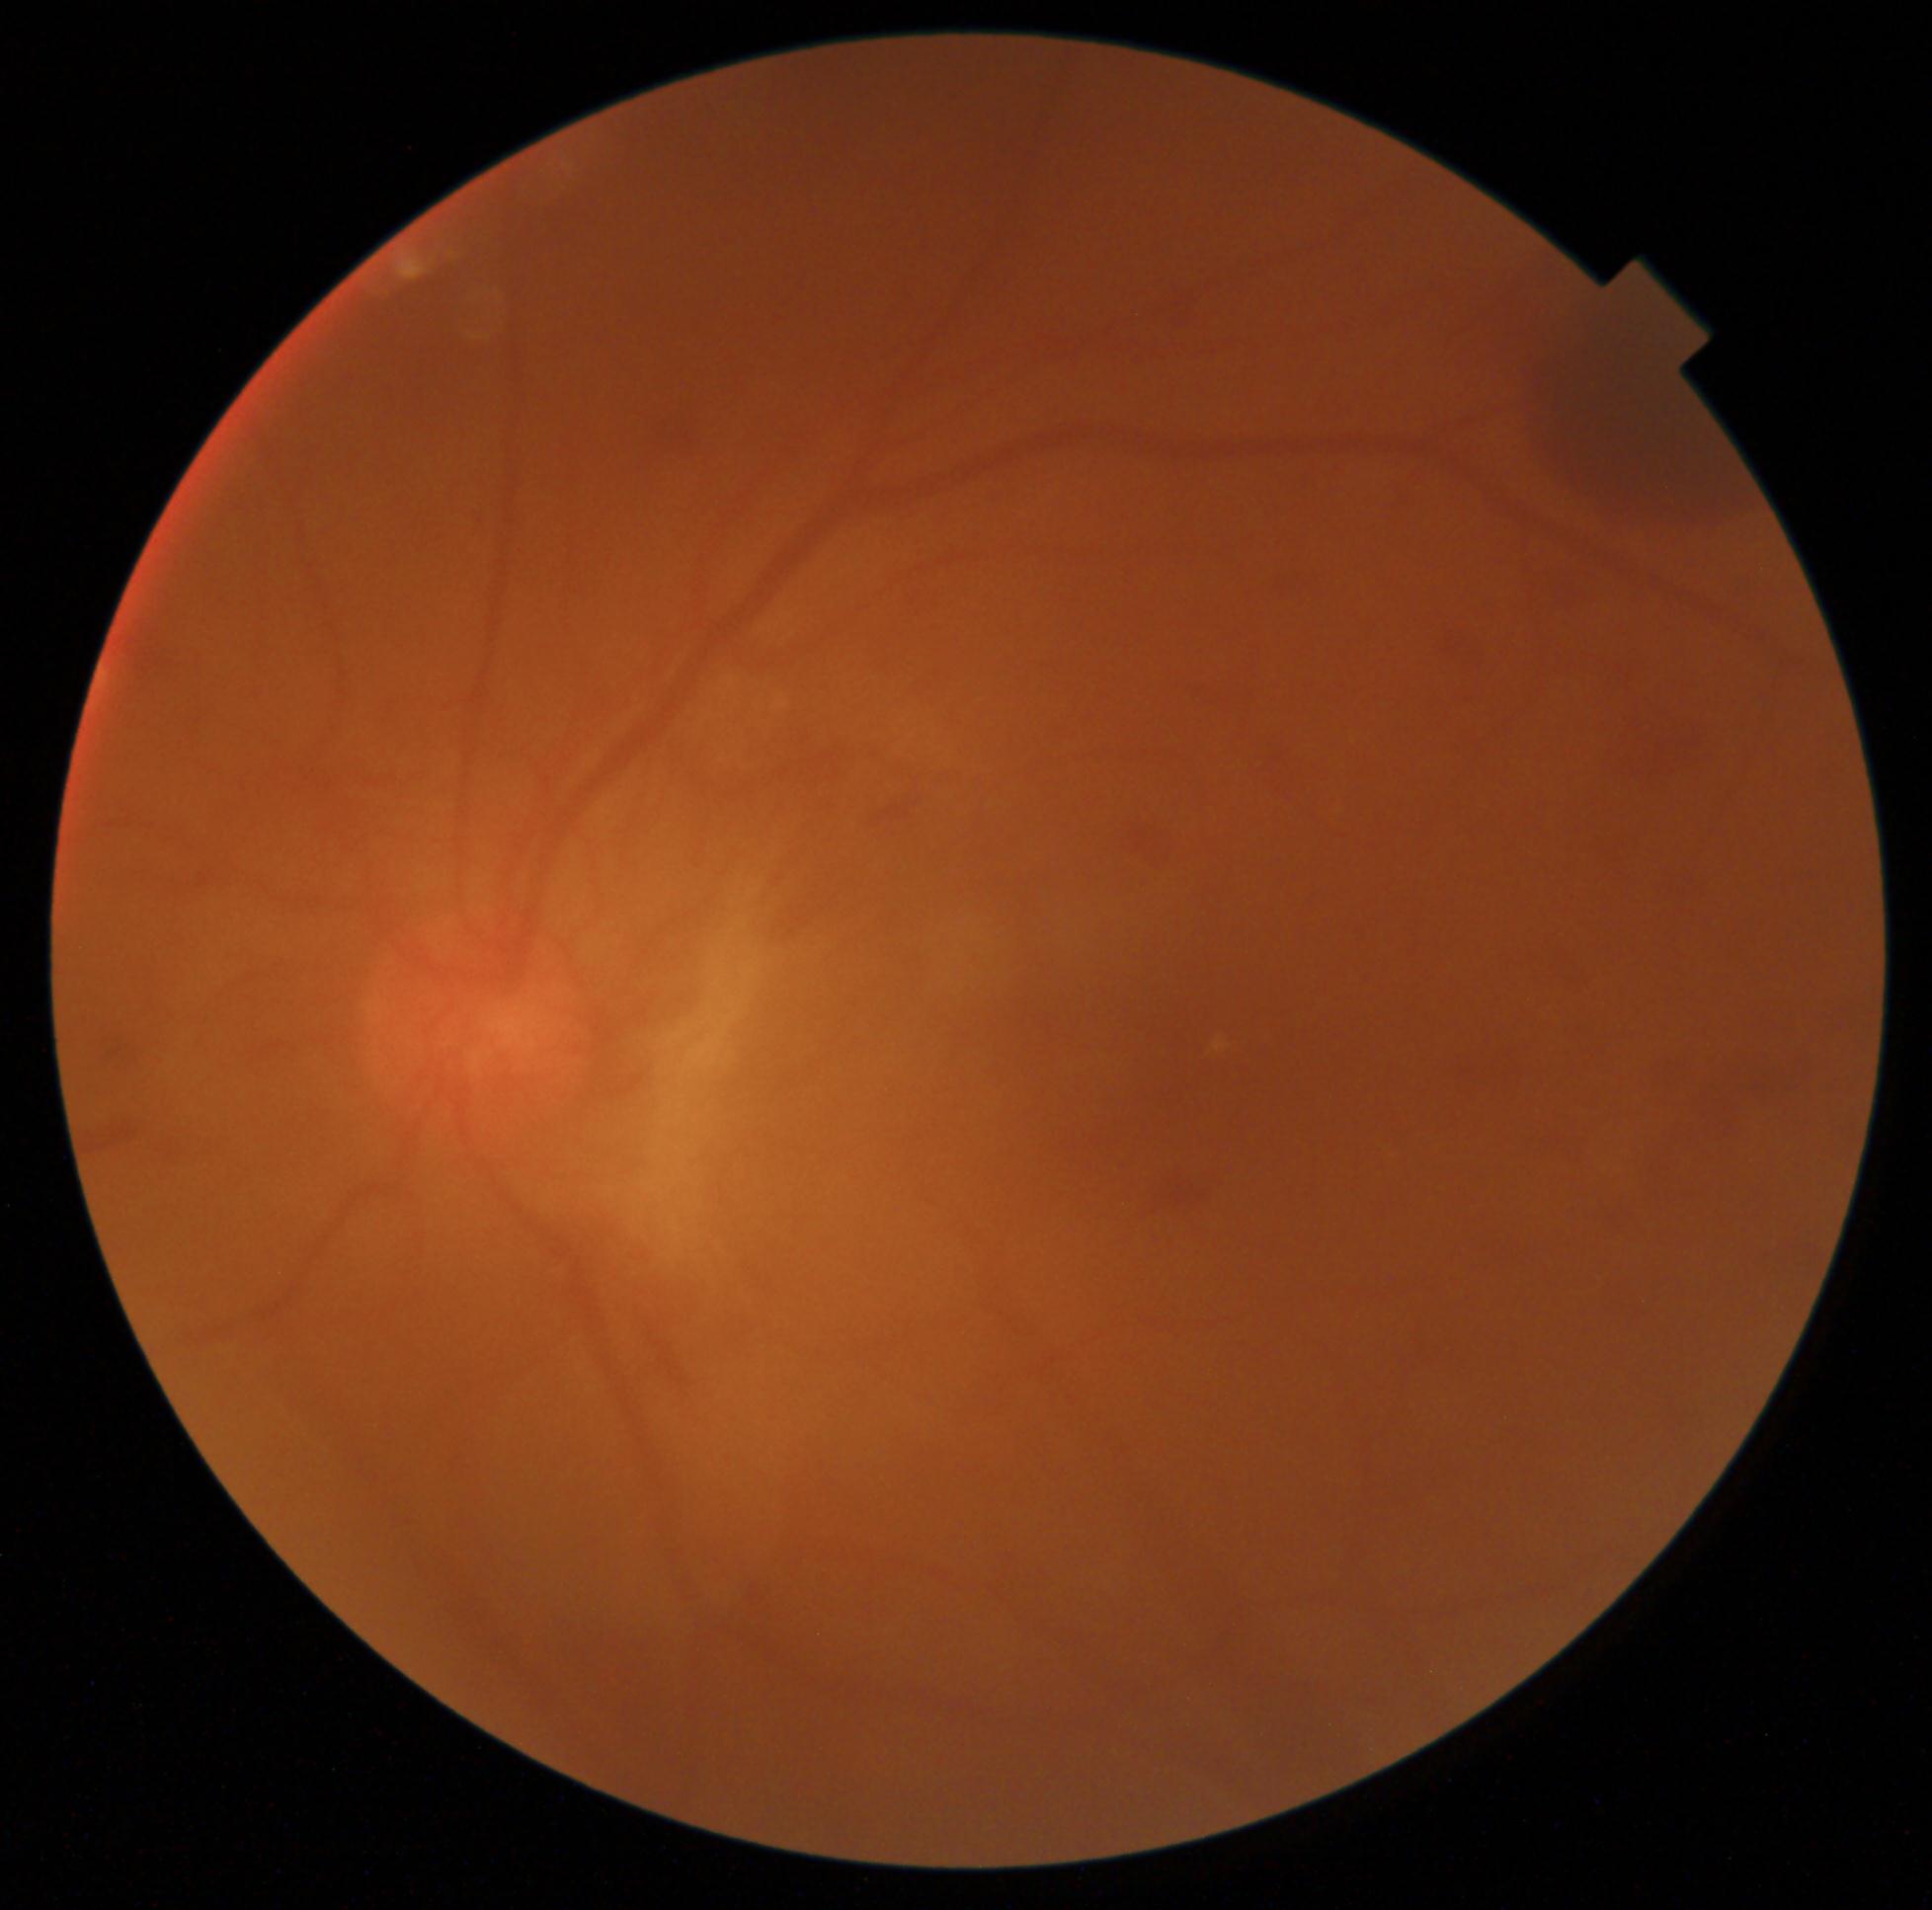

DR stage=grade 4 (PDR); DR class=proliferative diabetic retinopathy.